2212 by 1659 pixels · CFP · FOV: 45 degrees — 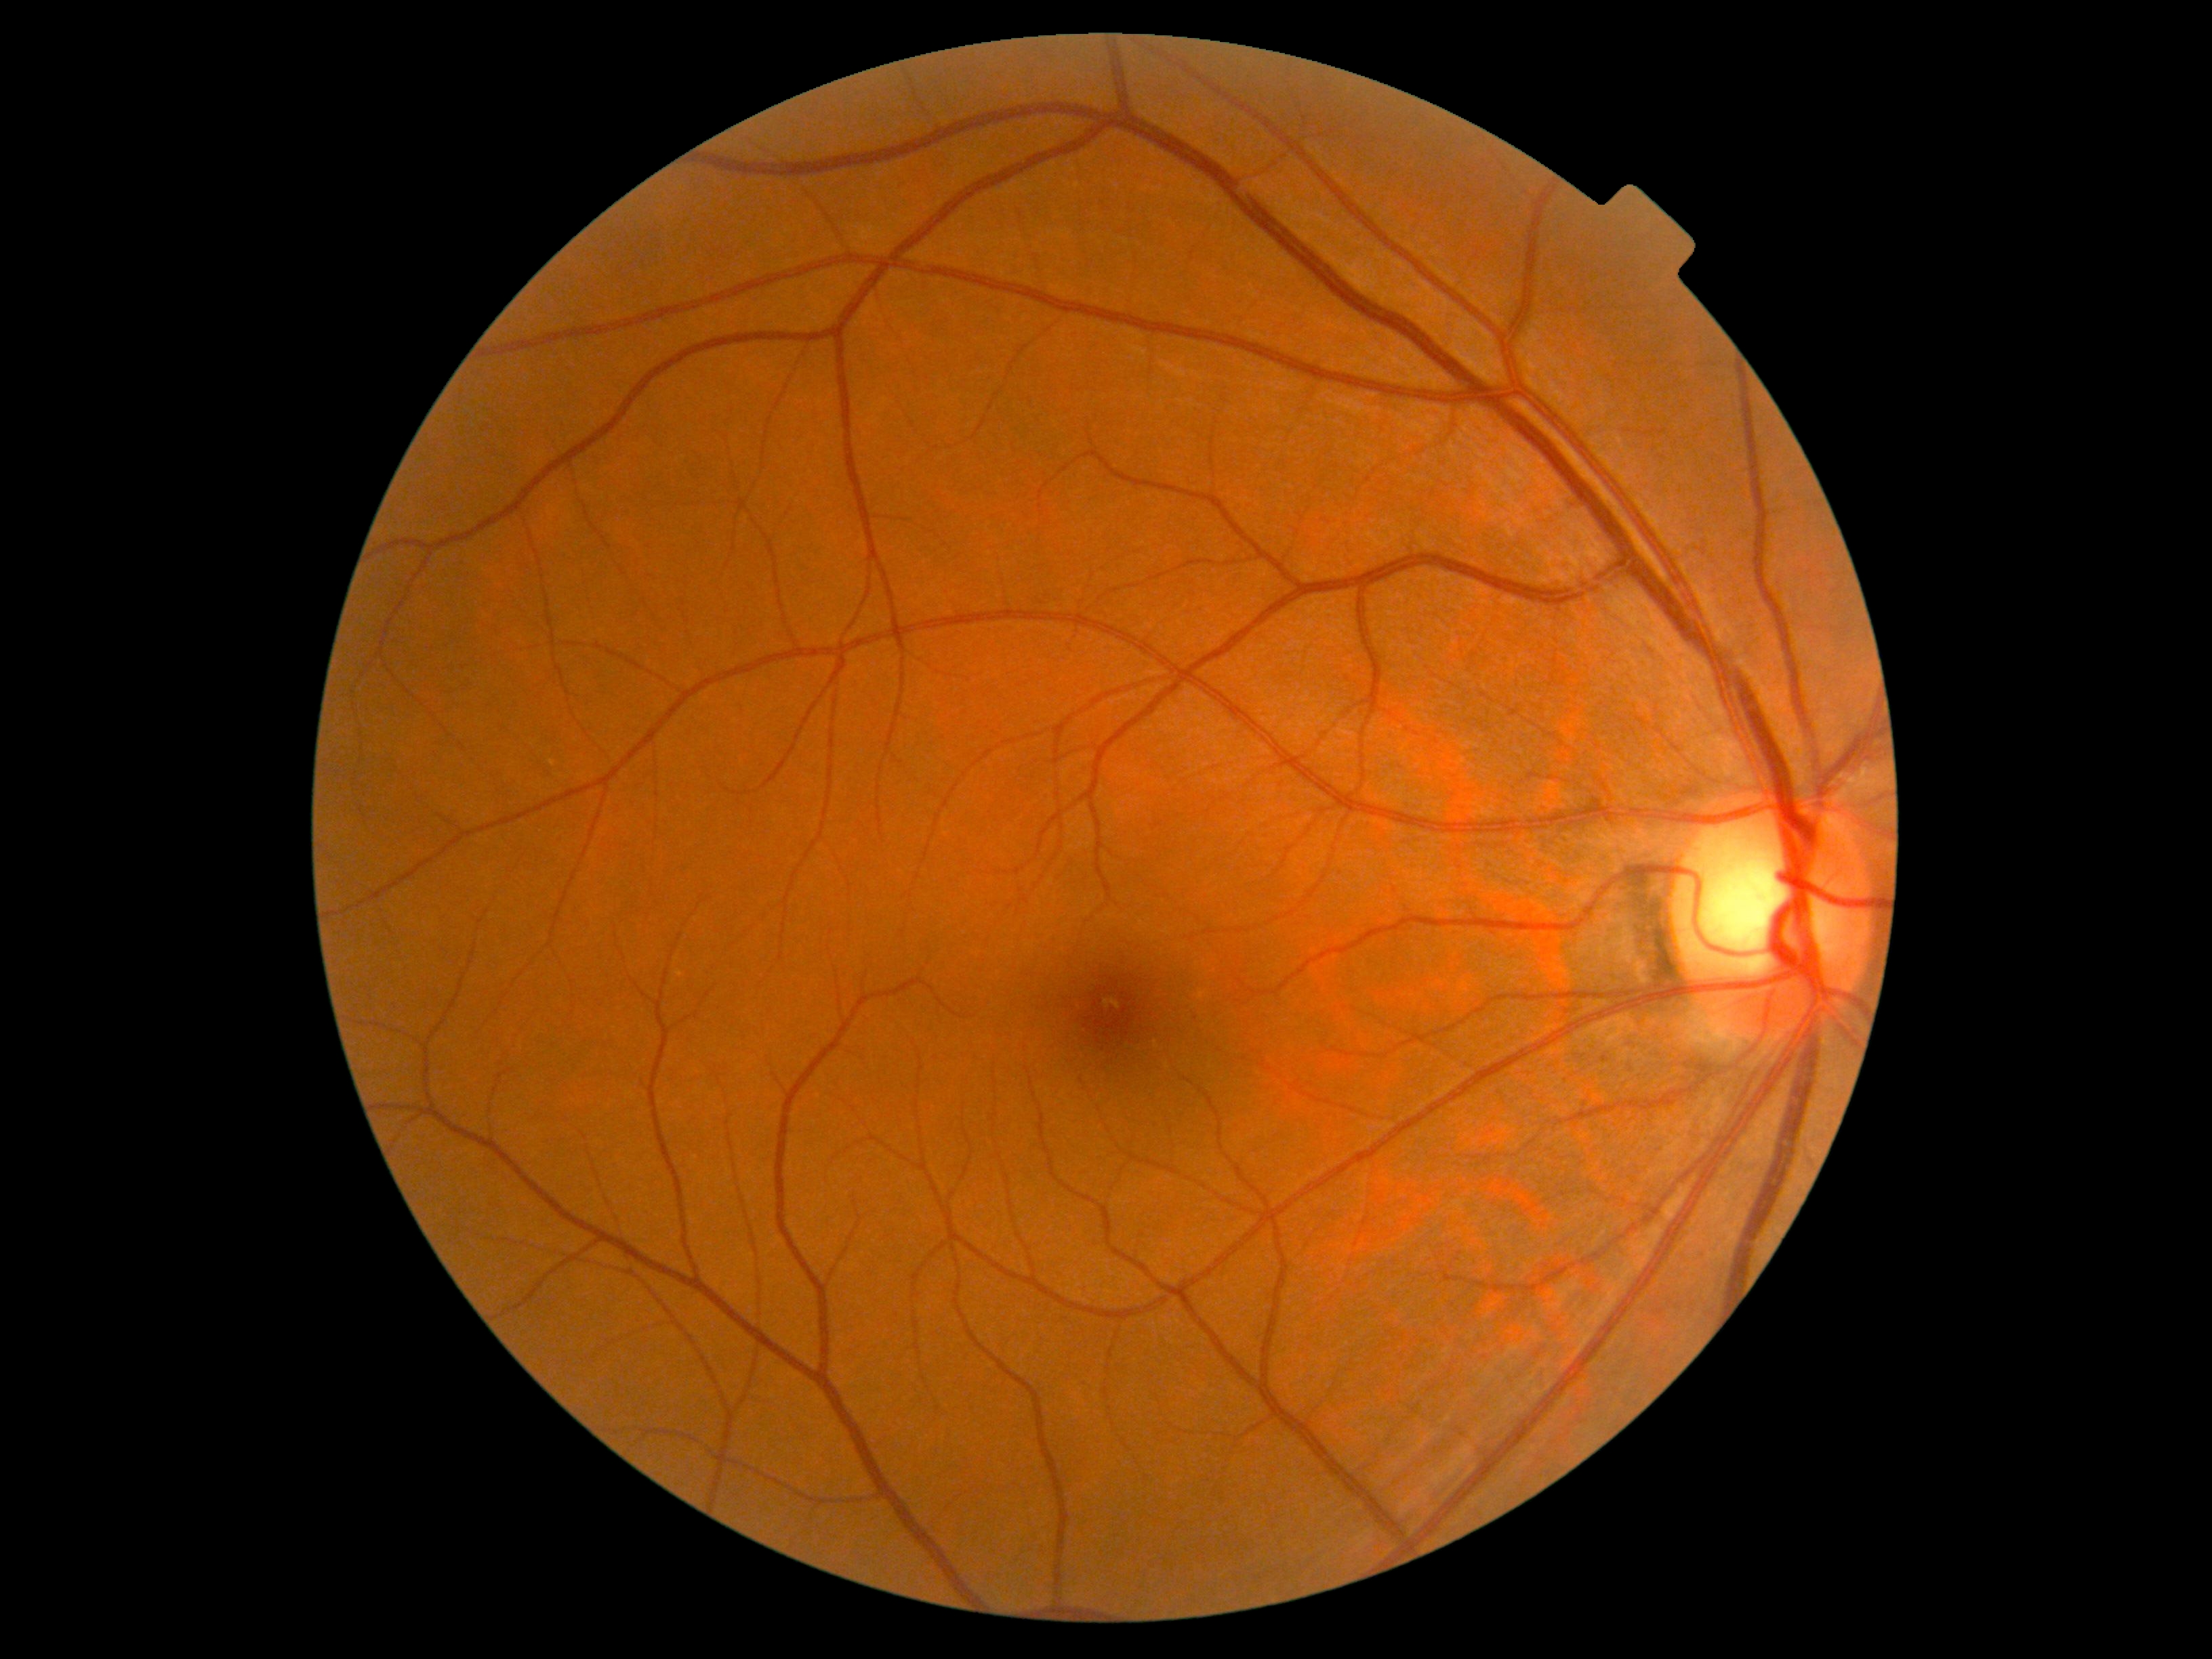

DR impression=no signs of DR; diabetic retinopathy grade=no apparent diabetic retinopathy (0).